Diabetic retinopathy graded by the modified Davis classification, nonmydriatic fundus photograph — 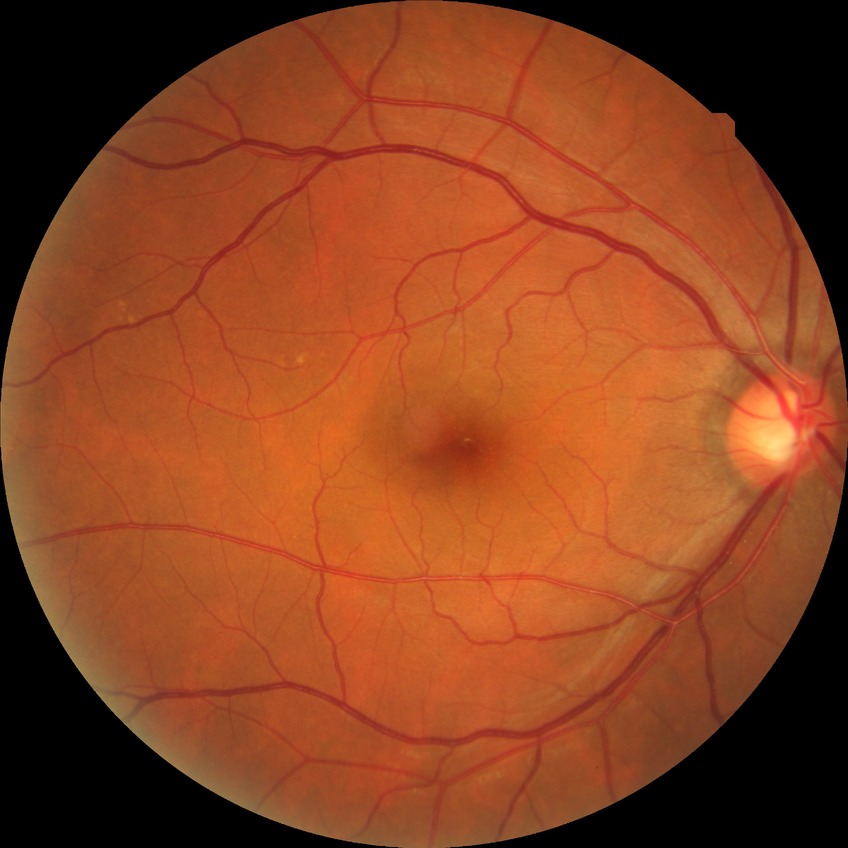

diabetic retinopathy (DR) = no diabetic retinopathy (NDR).